45-degree field of view — 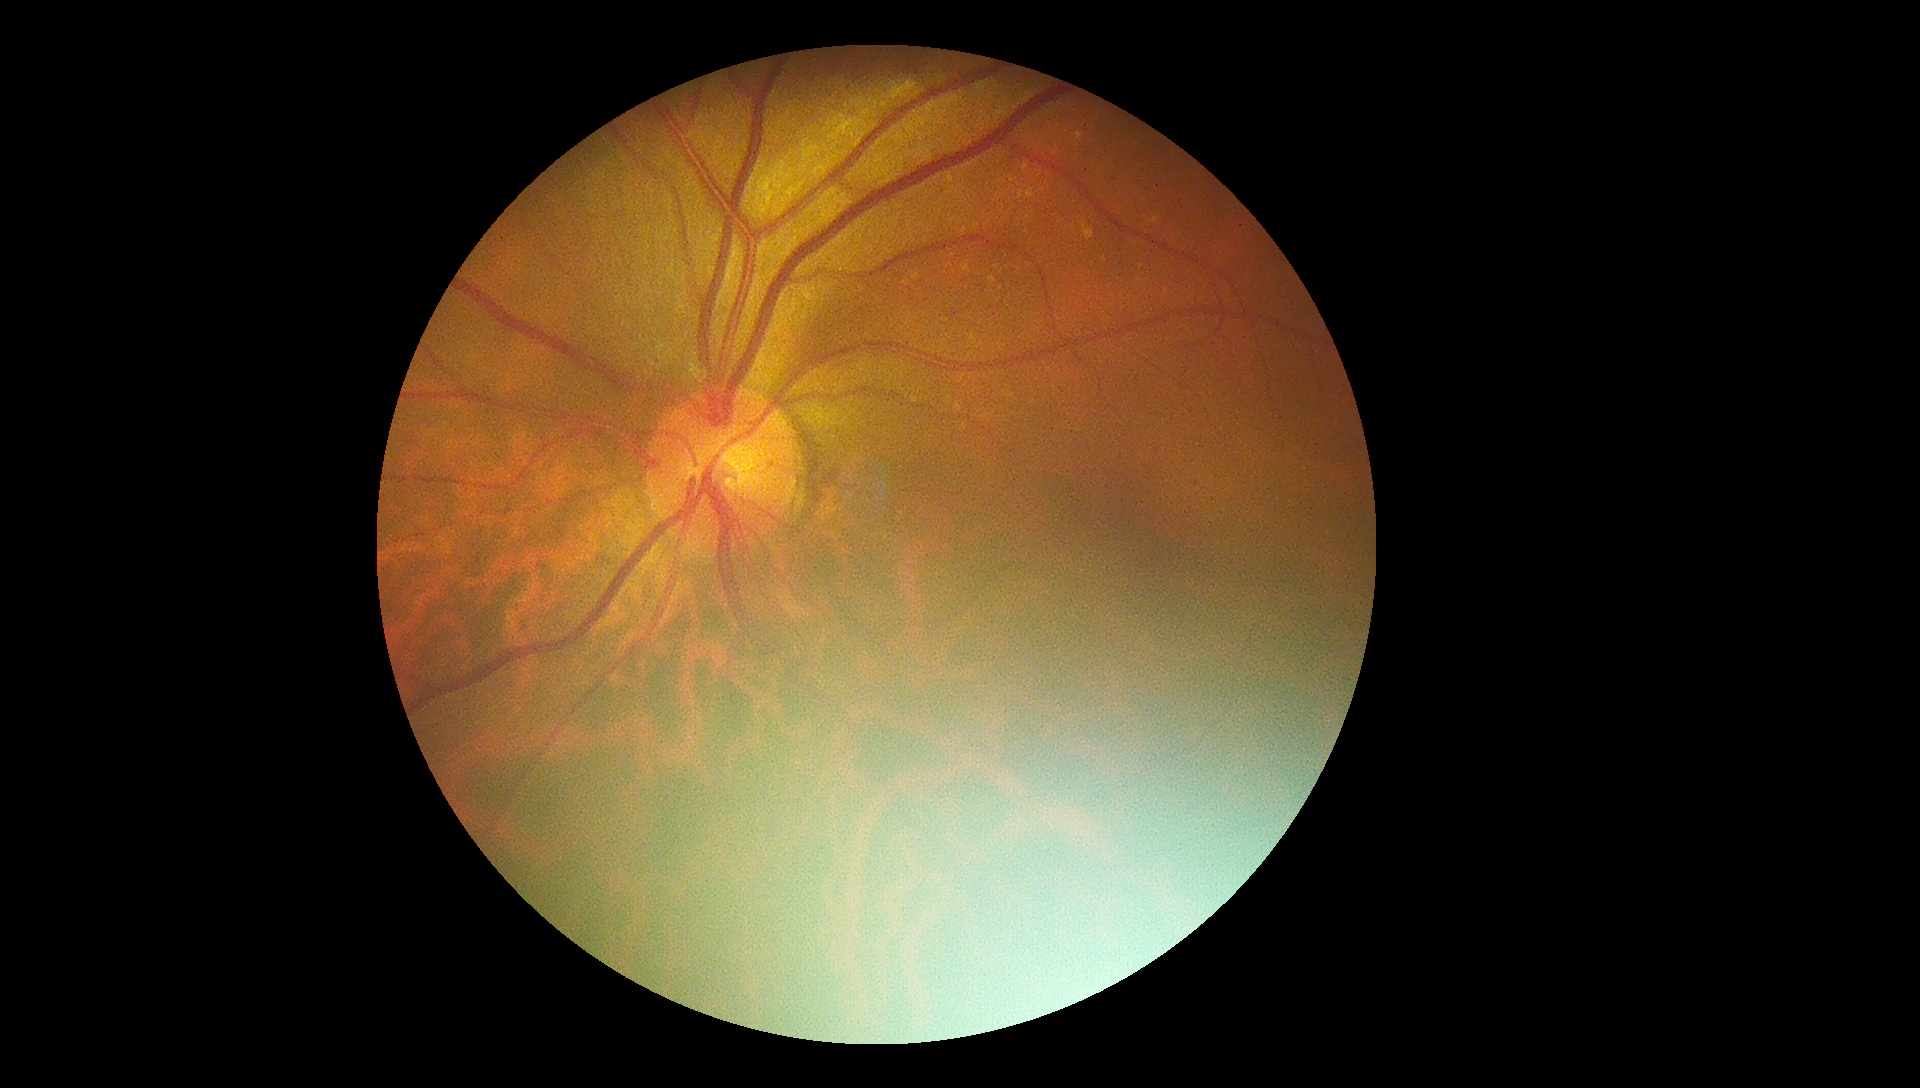
DR class: non-proliferative diabetic retinopathy.
Diabetic retinopathy severity is 1.